Color fundus photograph: 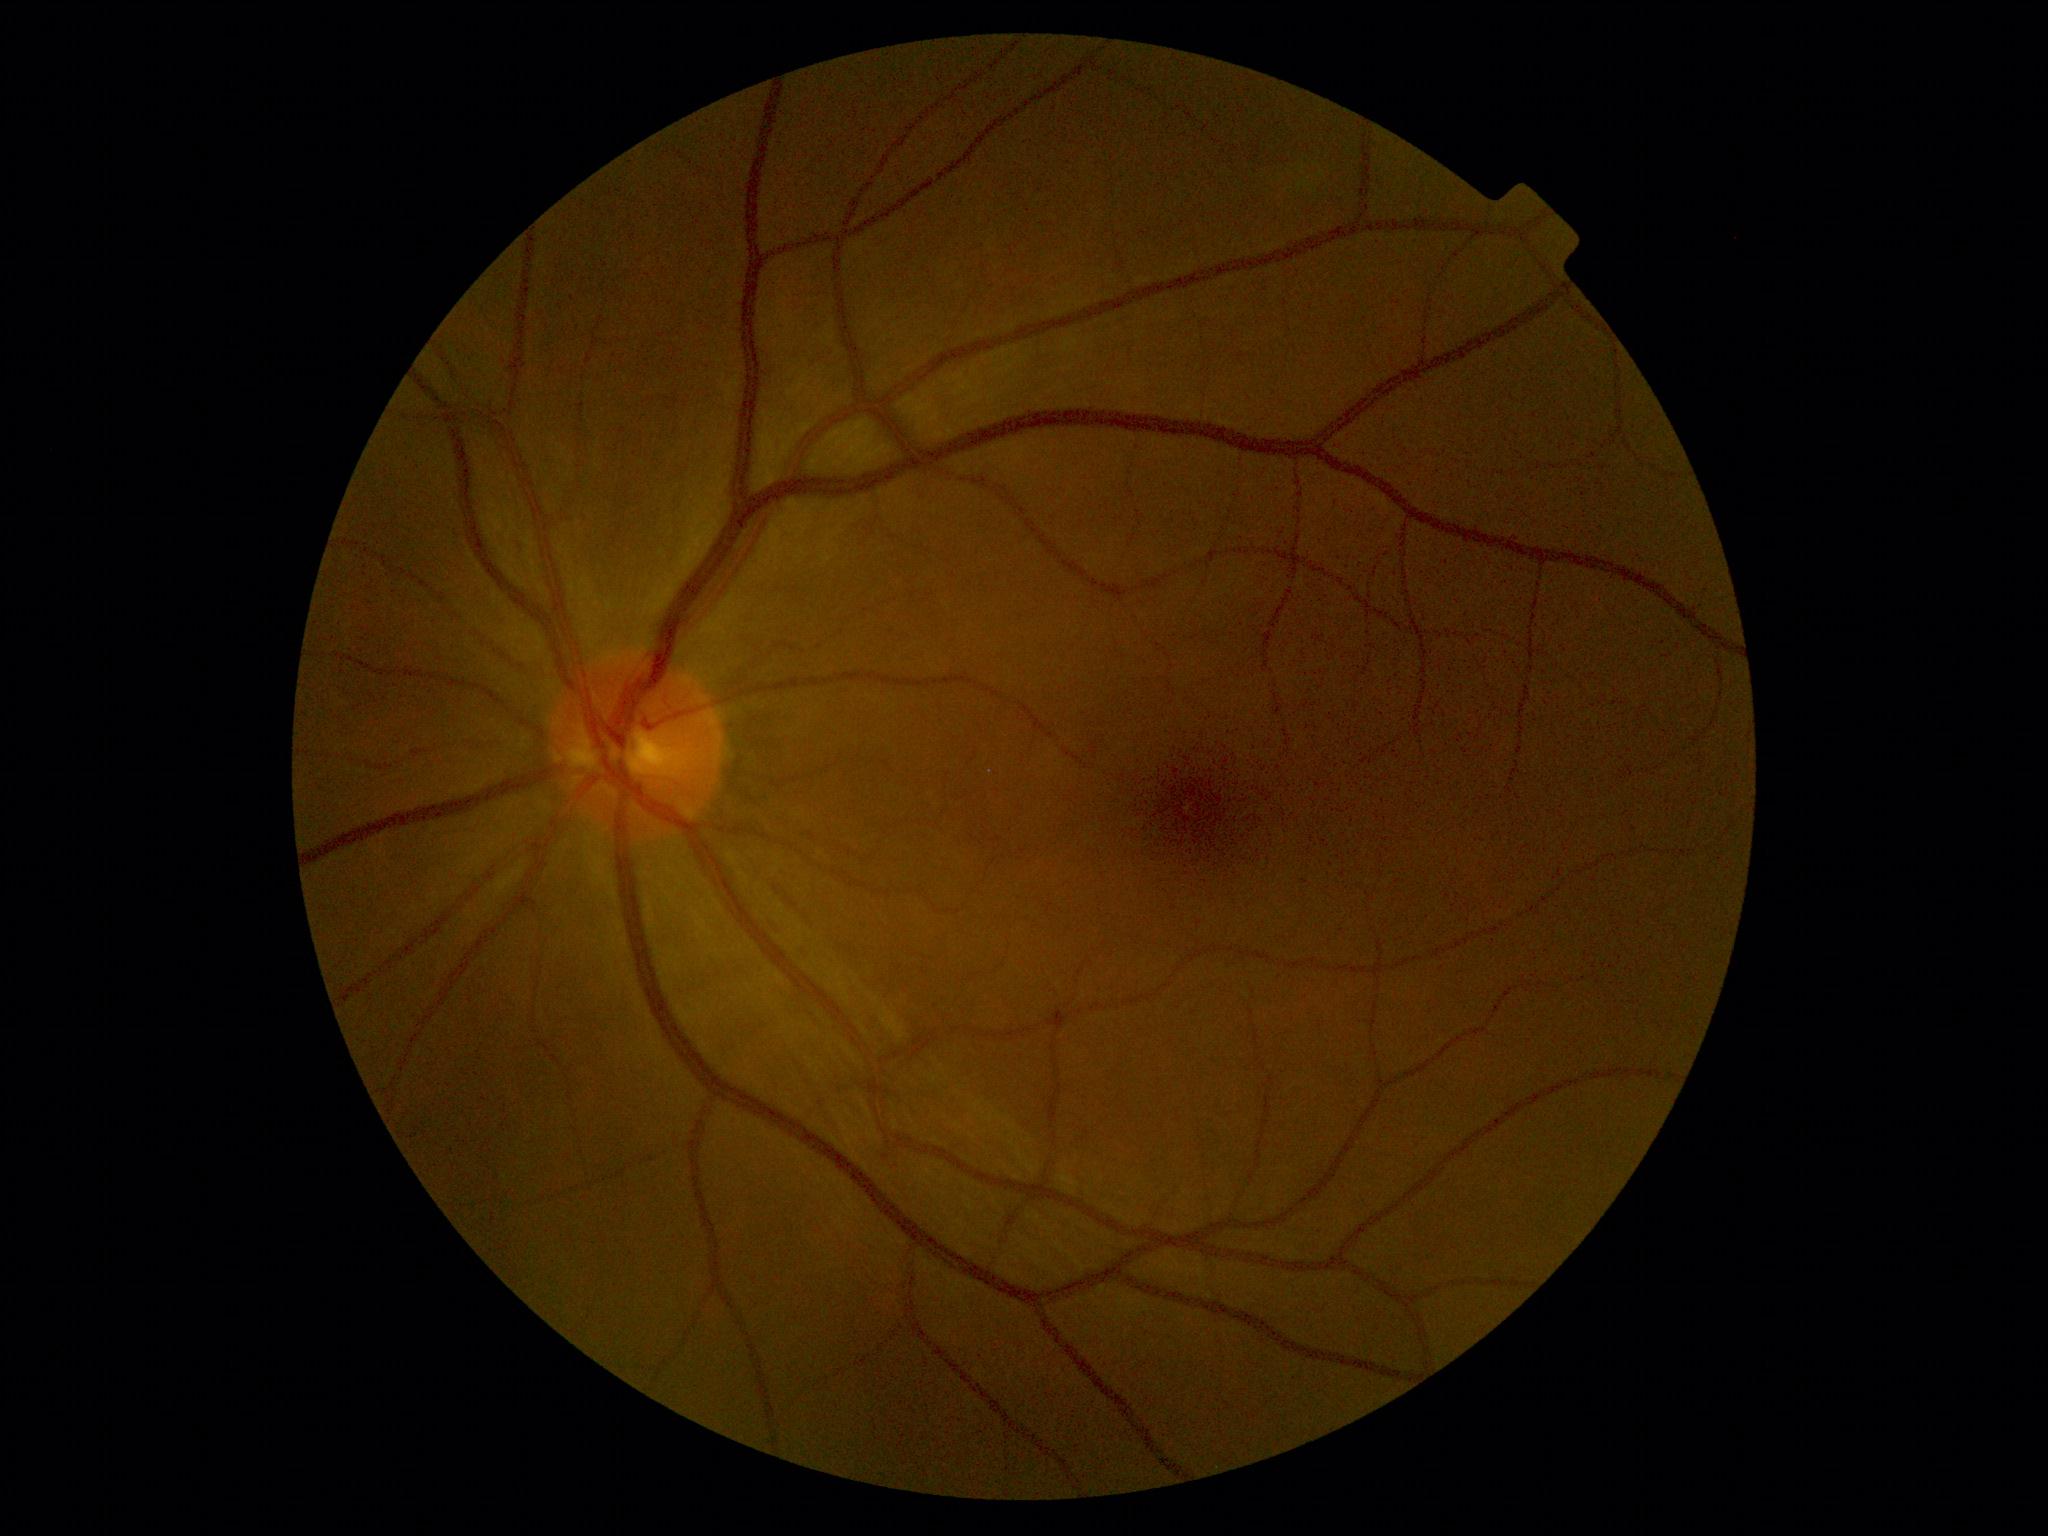
DR: 1.